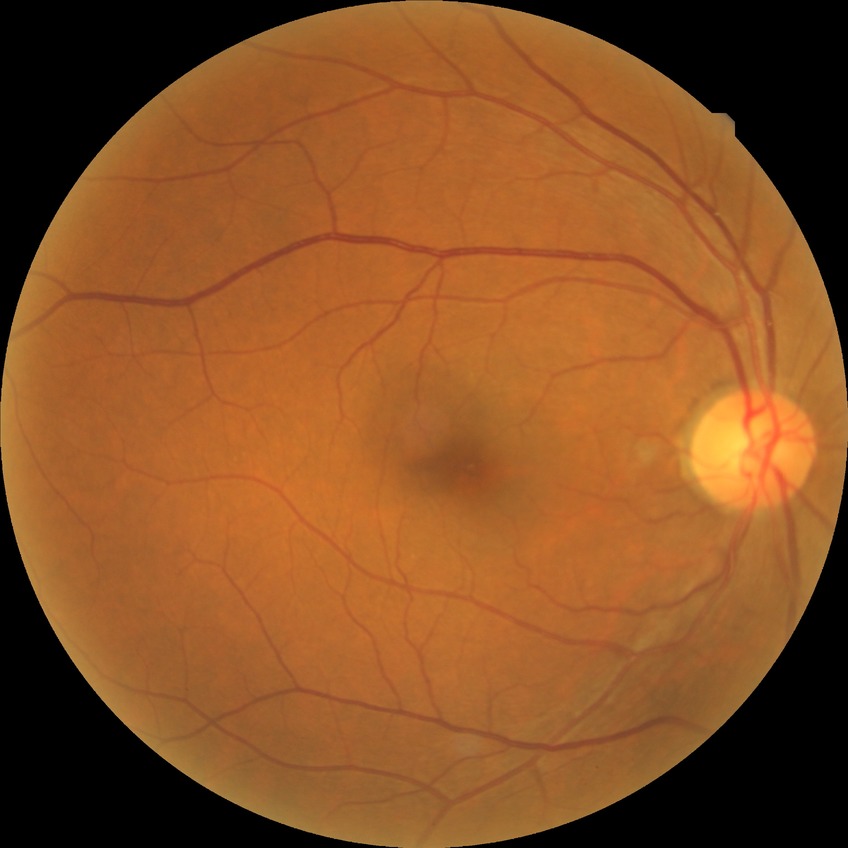
DR=NDR.